No pharmacologic dilation — 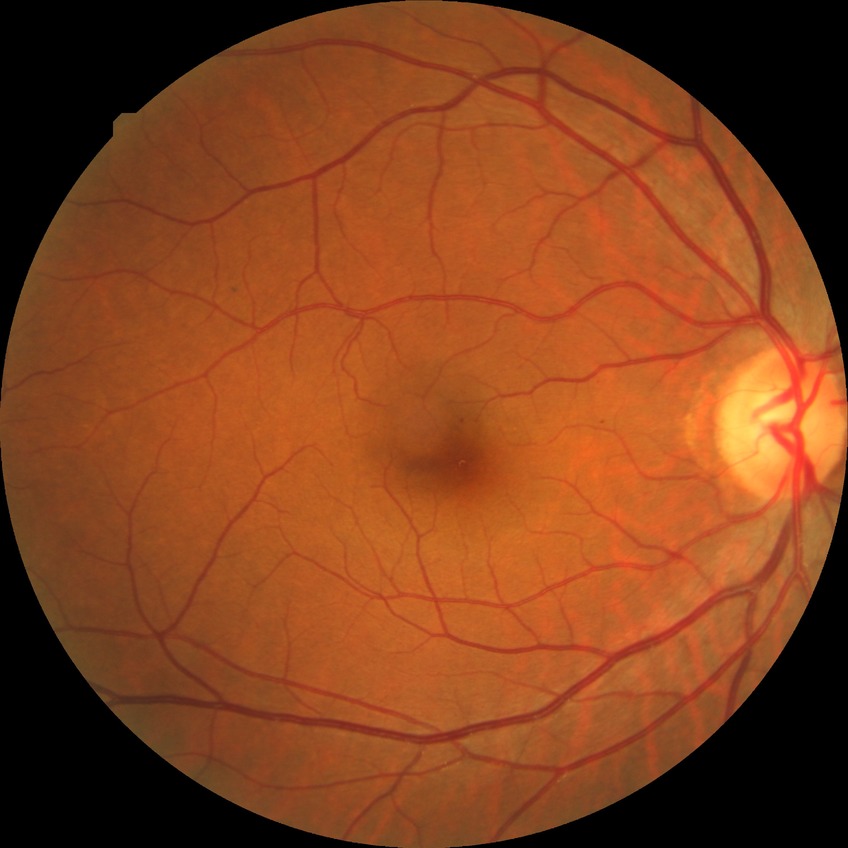

Diabetic retinopathy (DR): no diabetic retinopathy (NDR).